2352x1568 — 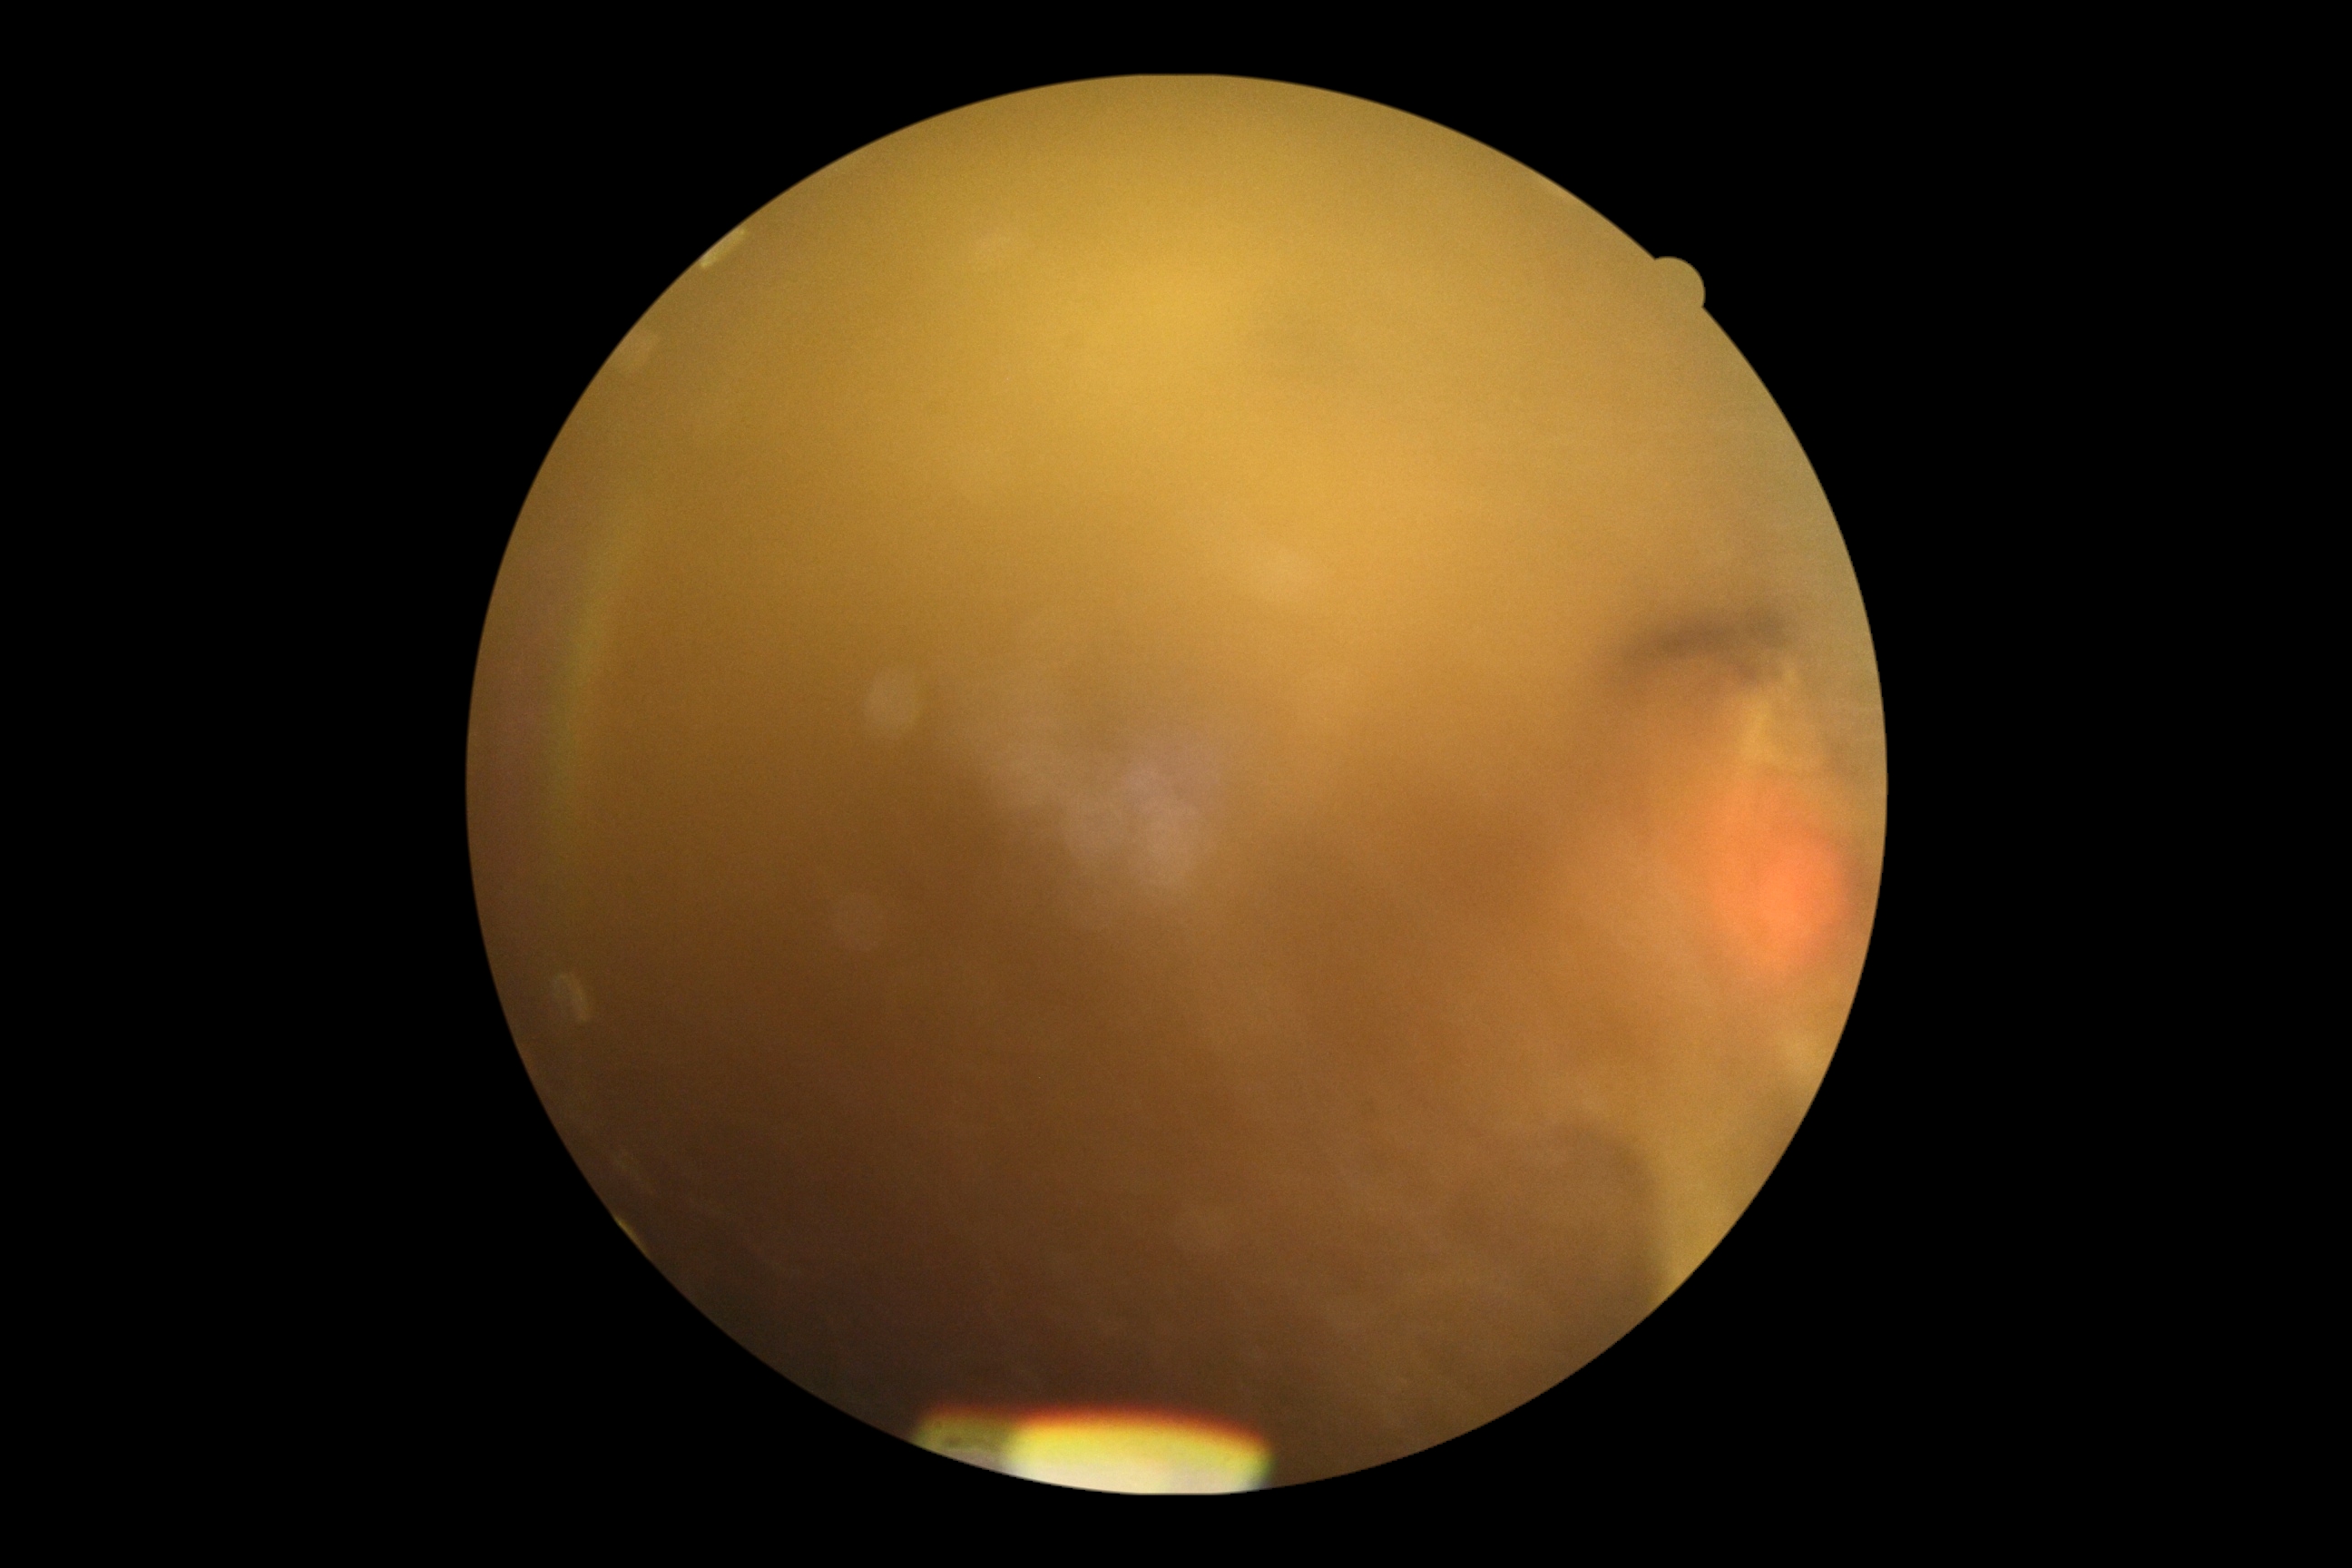
DR stage: ungradable. Ungradable image — DR severity cannot be determined.